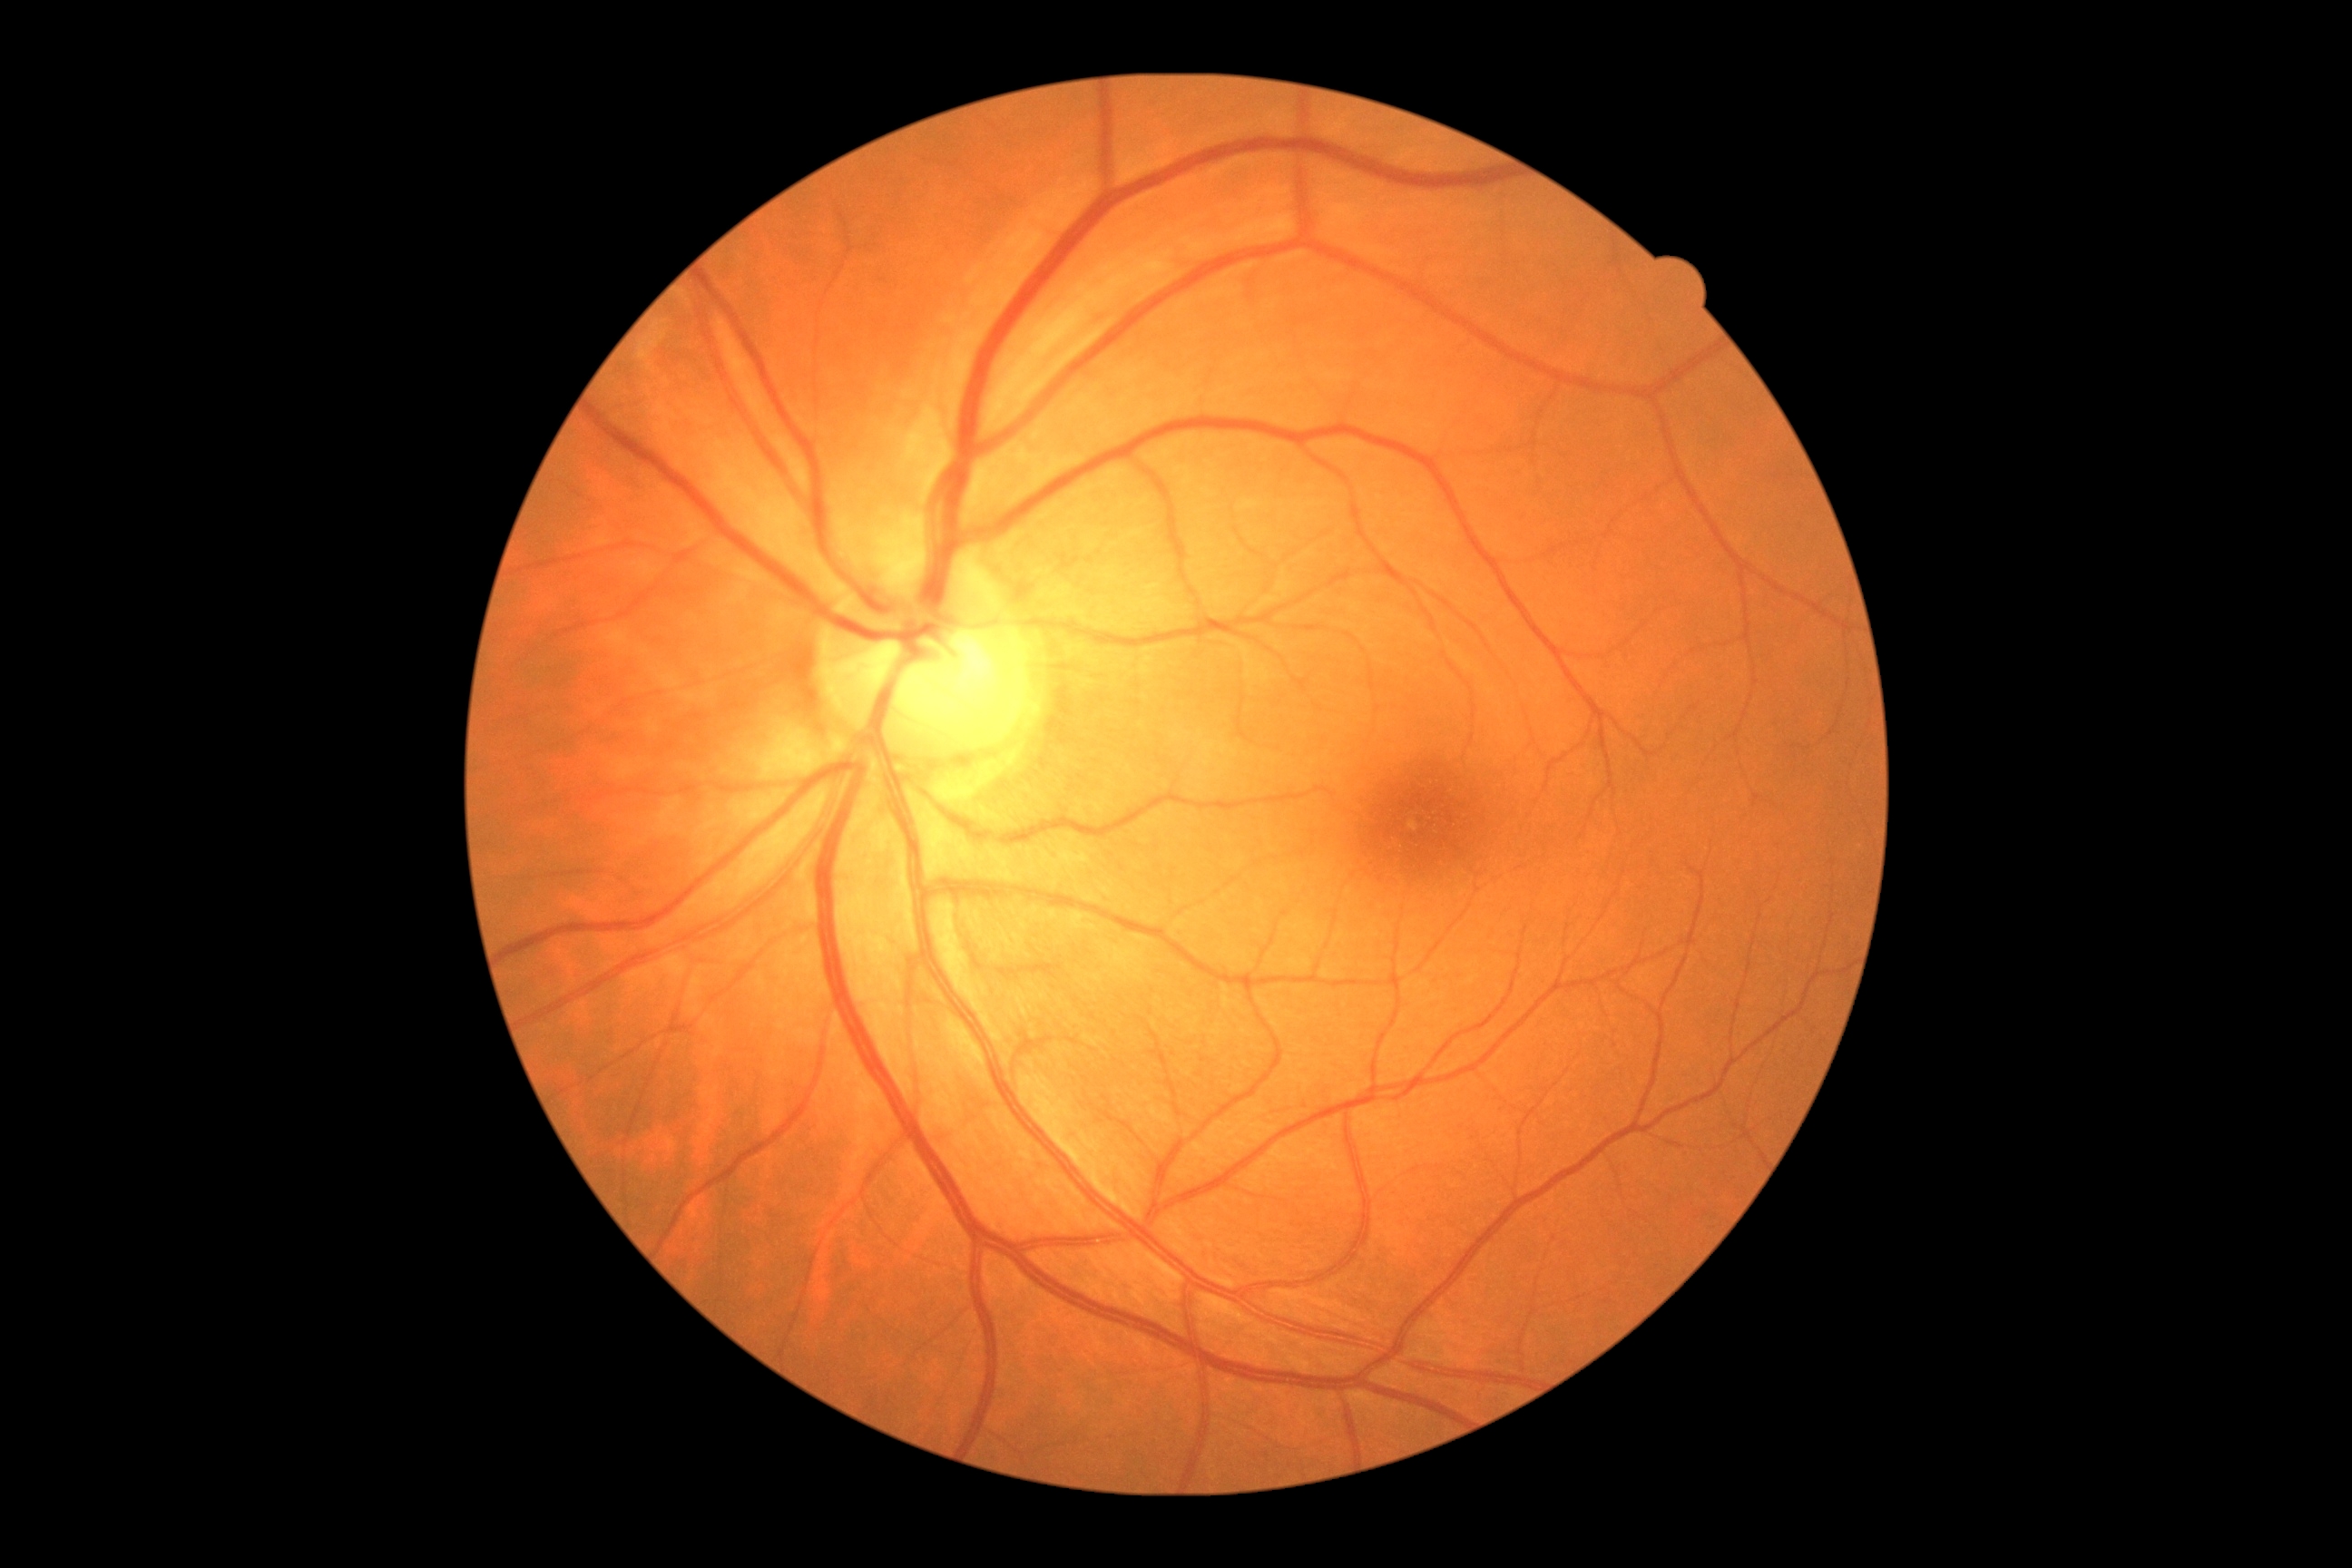
DR: grade 0 (no apparent retinopathy) — no visible signs of diabetic retinopathy.